NIDEK AFC-230, without pupil dilation — 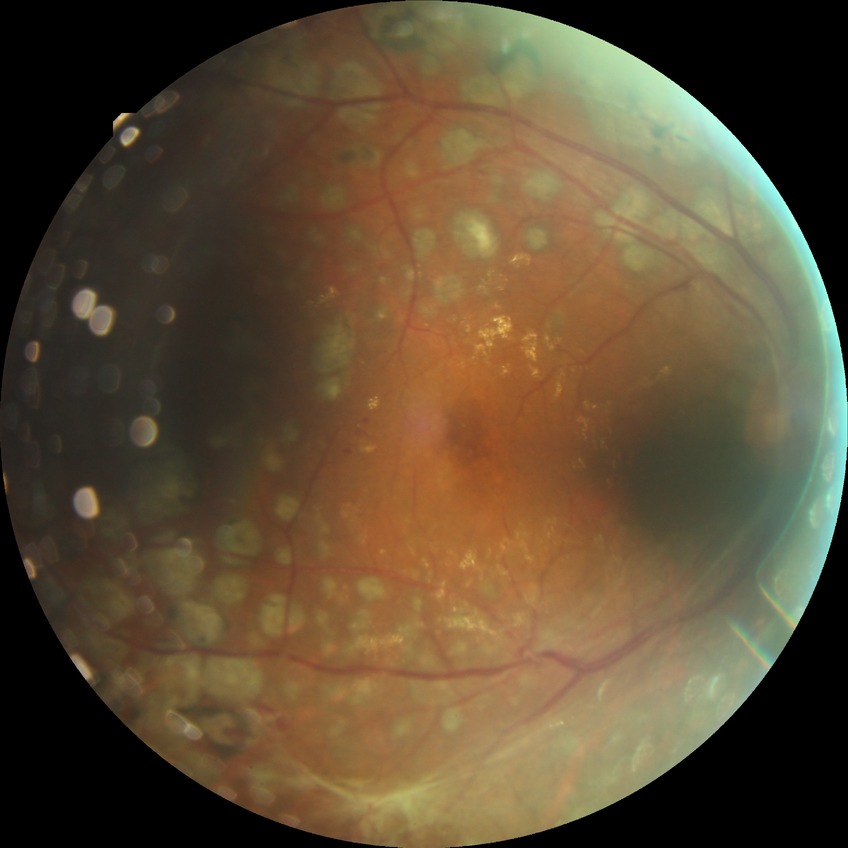

Diabetic retinopathy (DR) is proliferative diabetic retinopathy (PDR).